Image size 2352x1568 · retinal fundus photograph · 45° FOV: 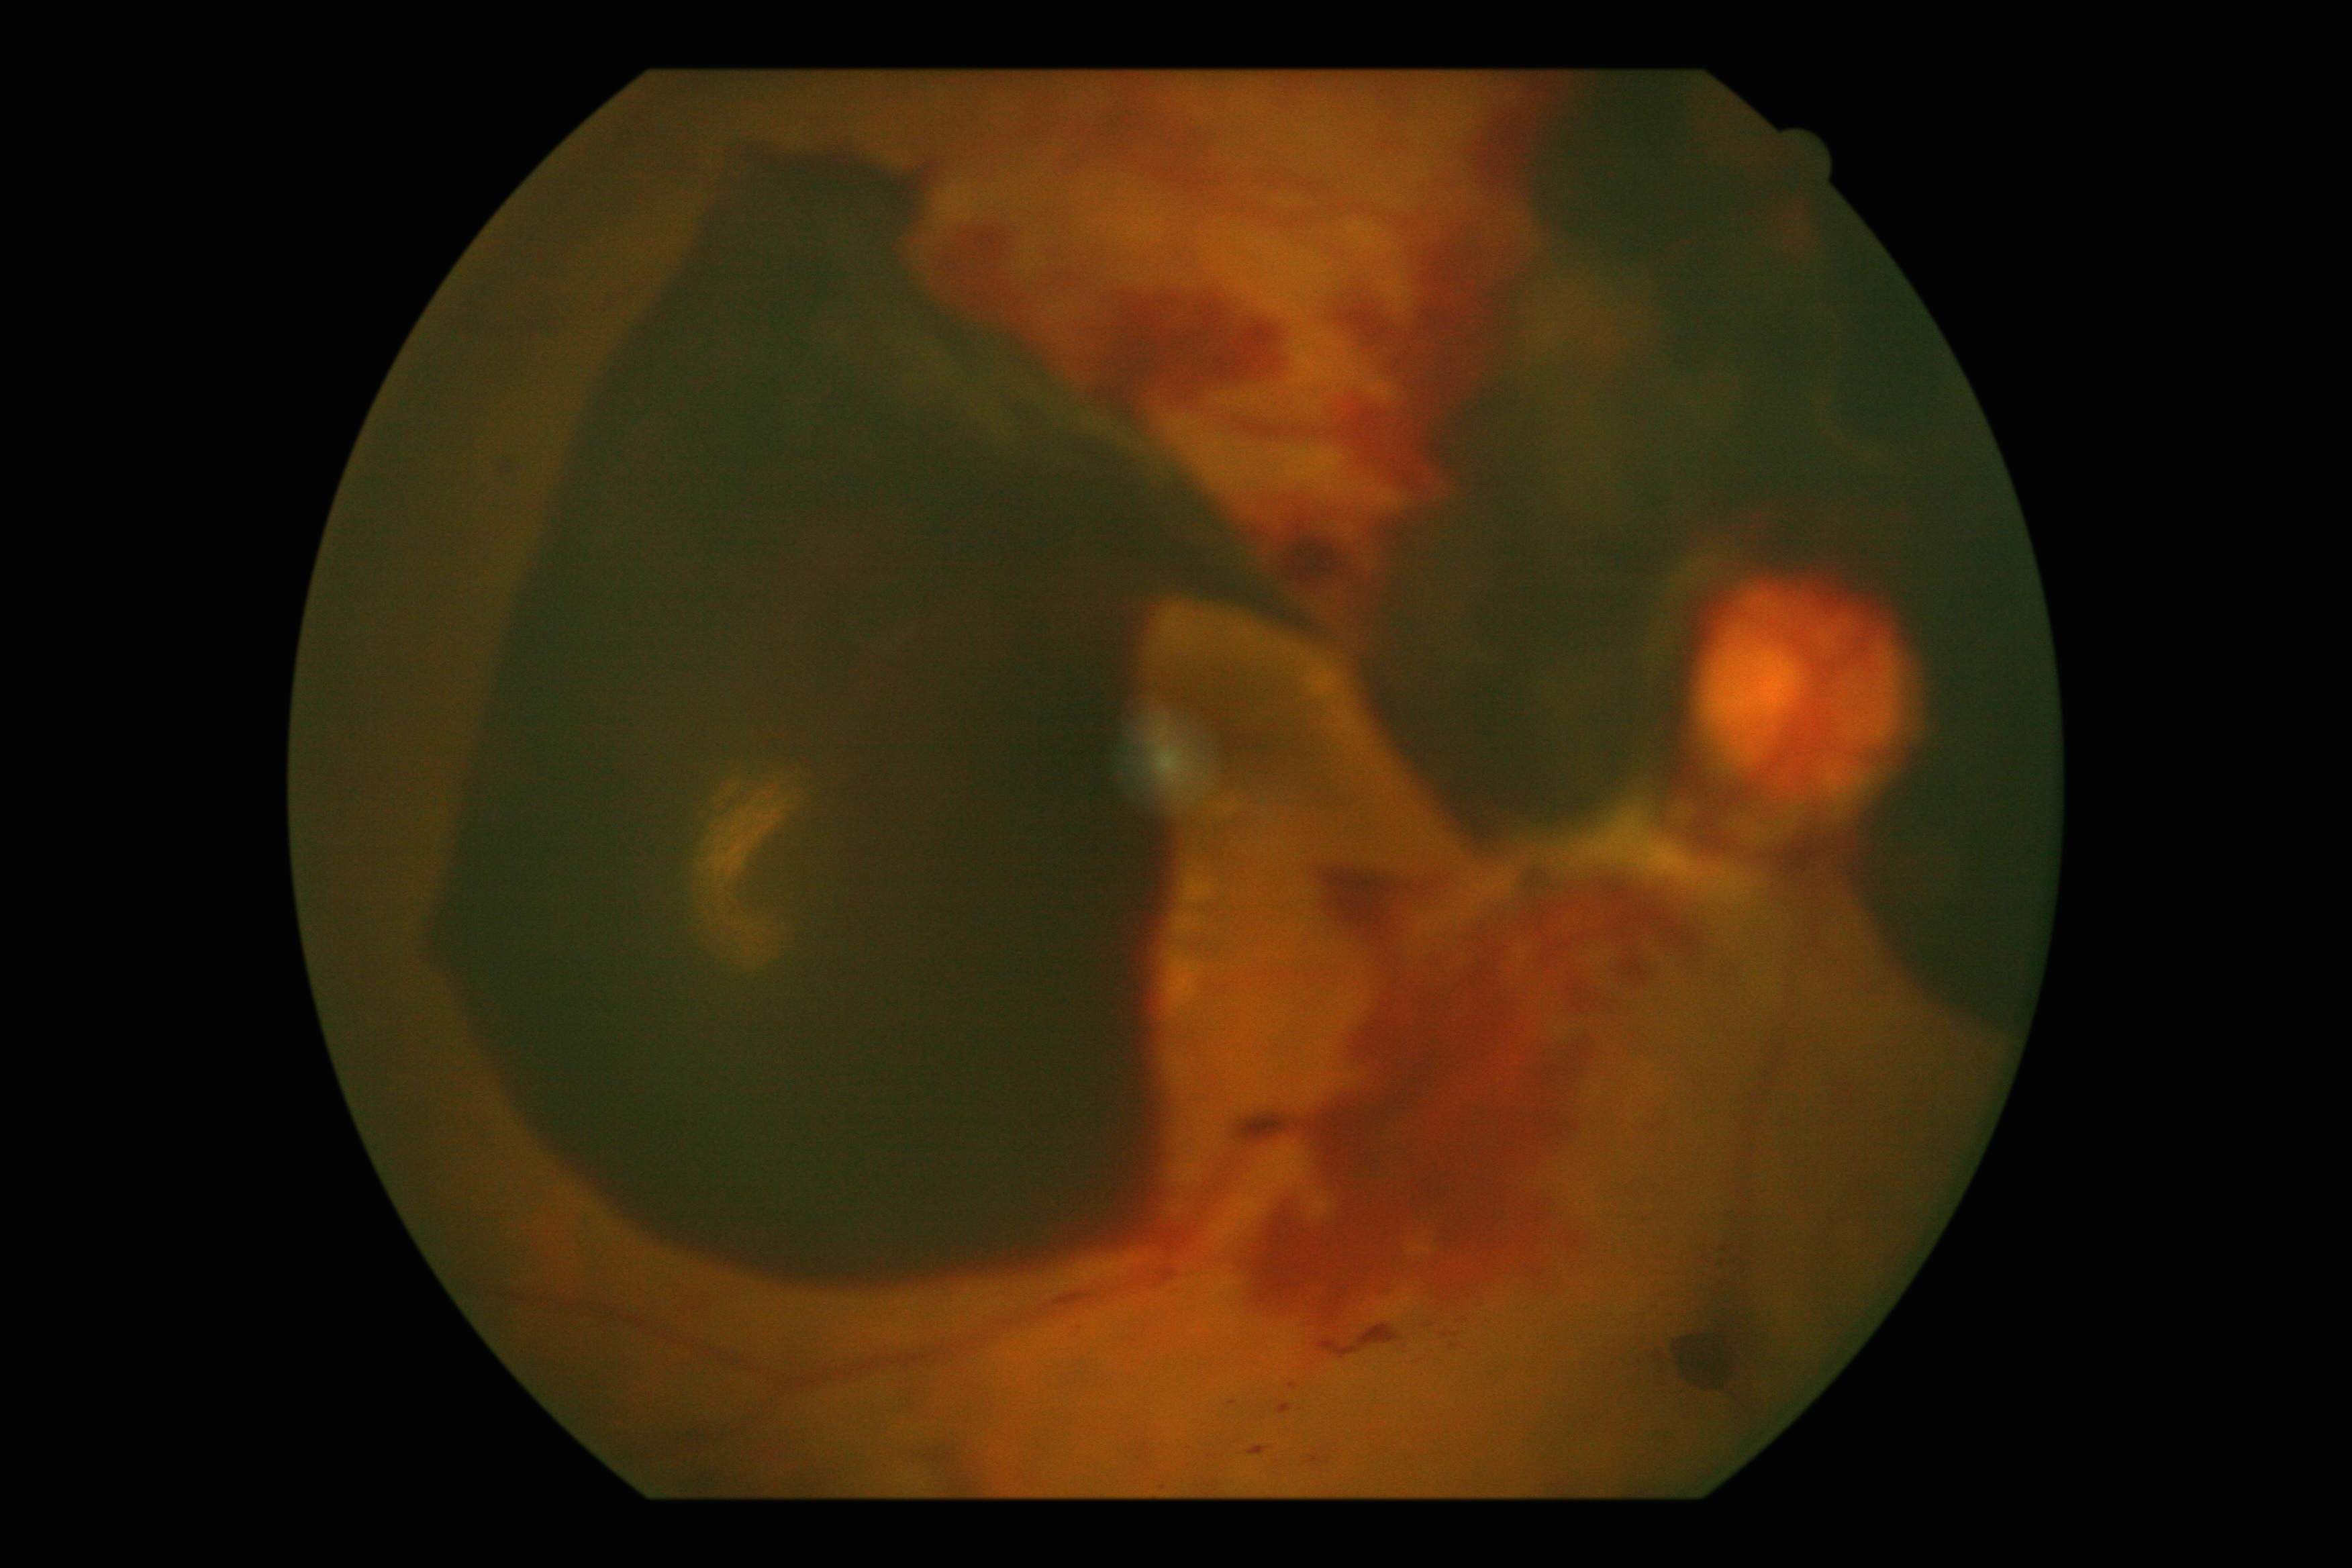

DR is 4/4.